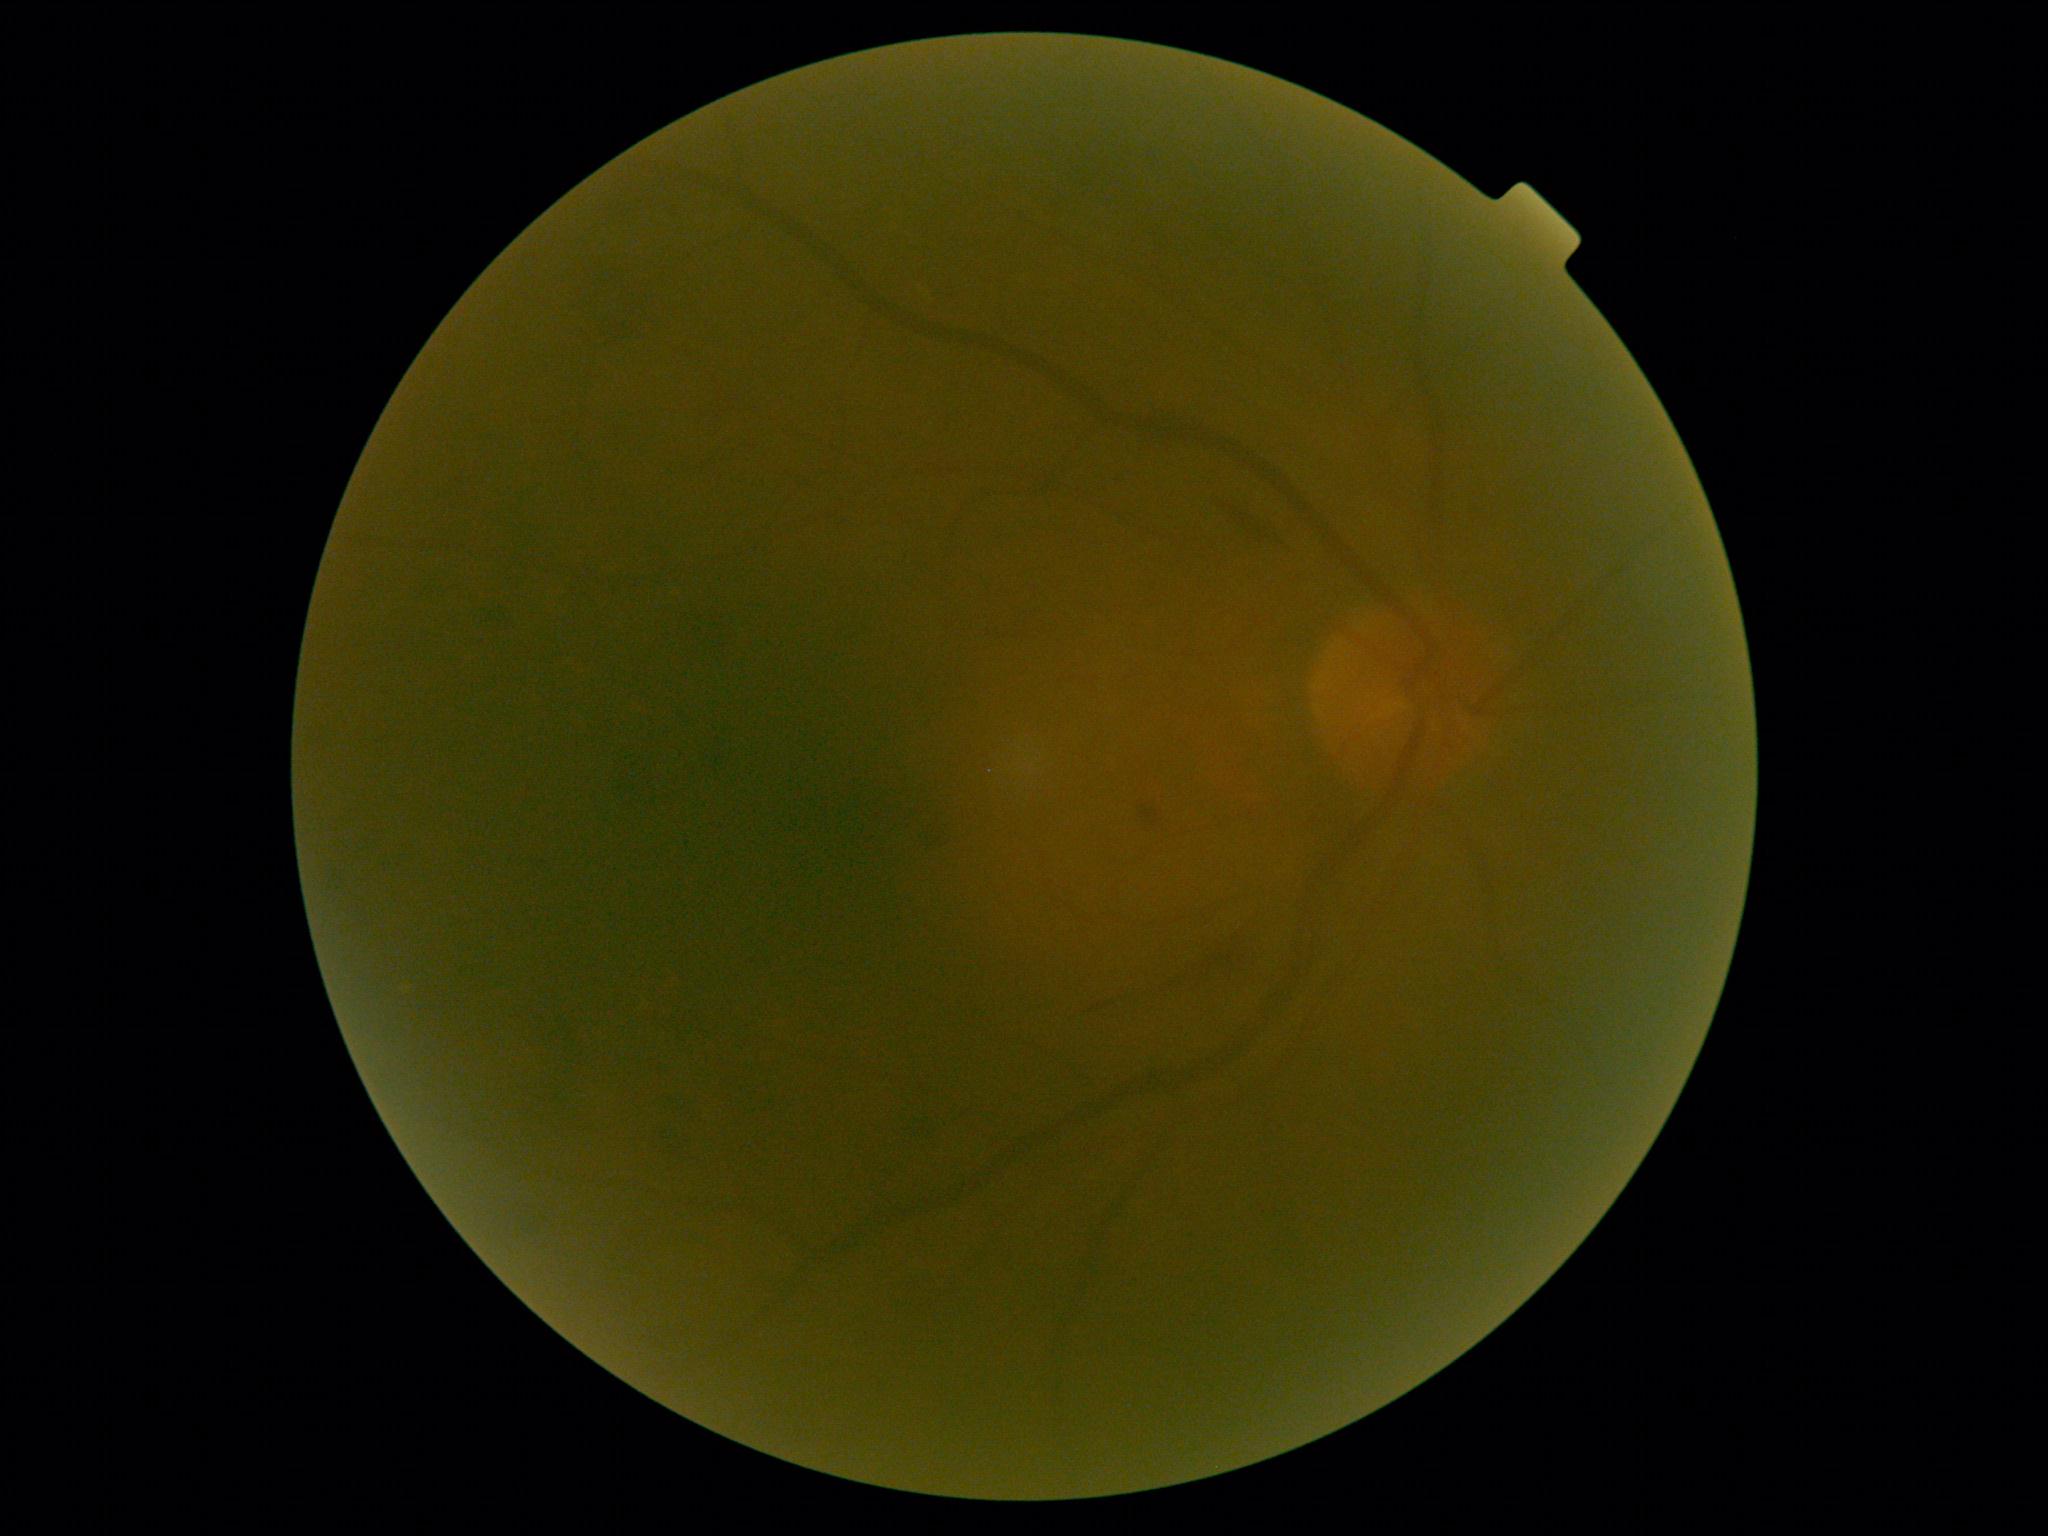

DR = grade 2 (moderate NPDR)